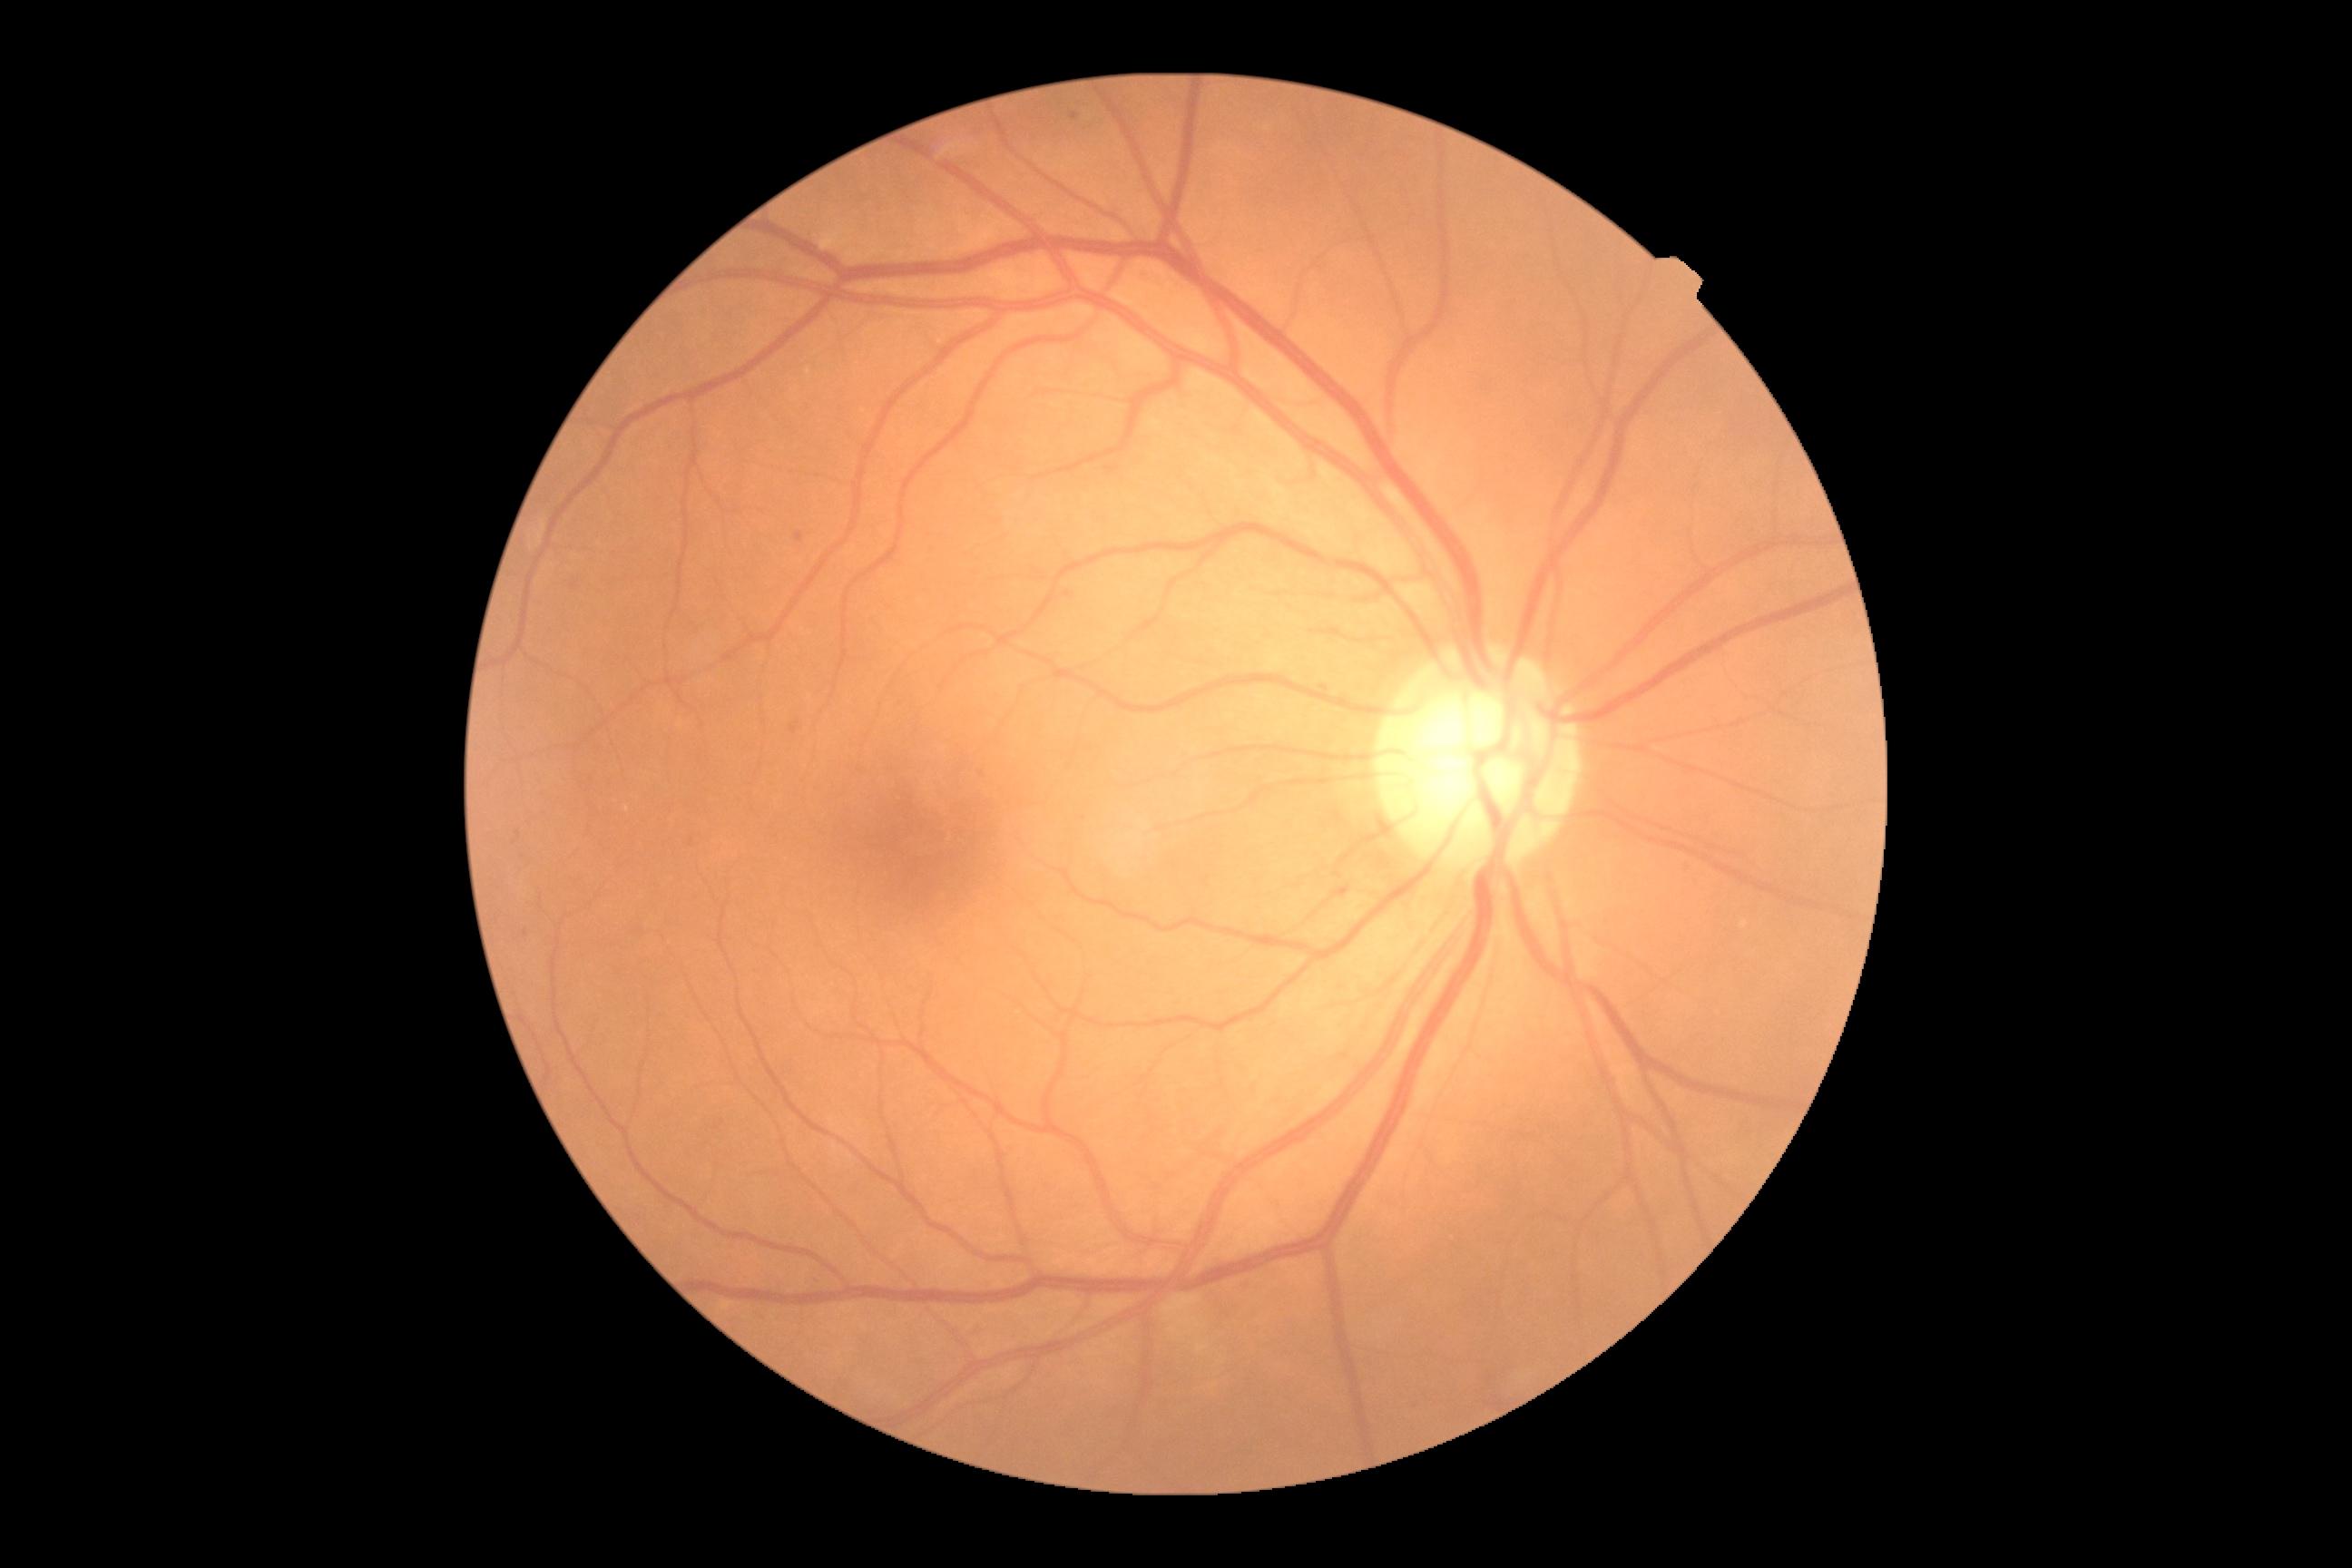

Retinopathy is moderate NPDR (grade 2).